Non-mydriatic acquisition — 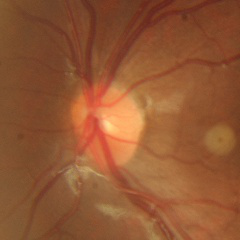 Glaucoma assessment: no glaucoma.